2352x1568.
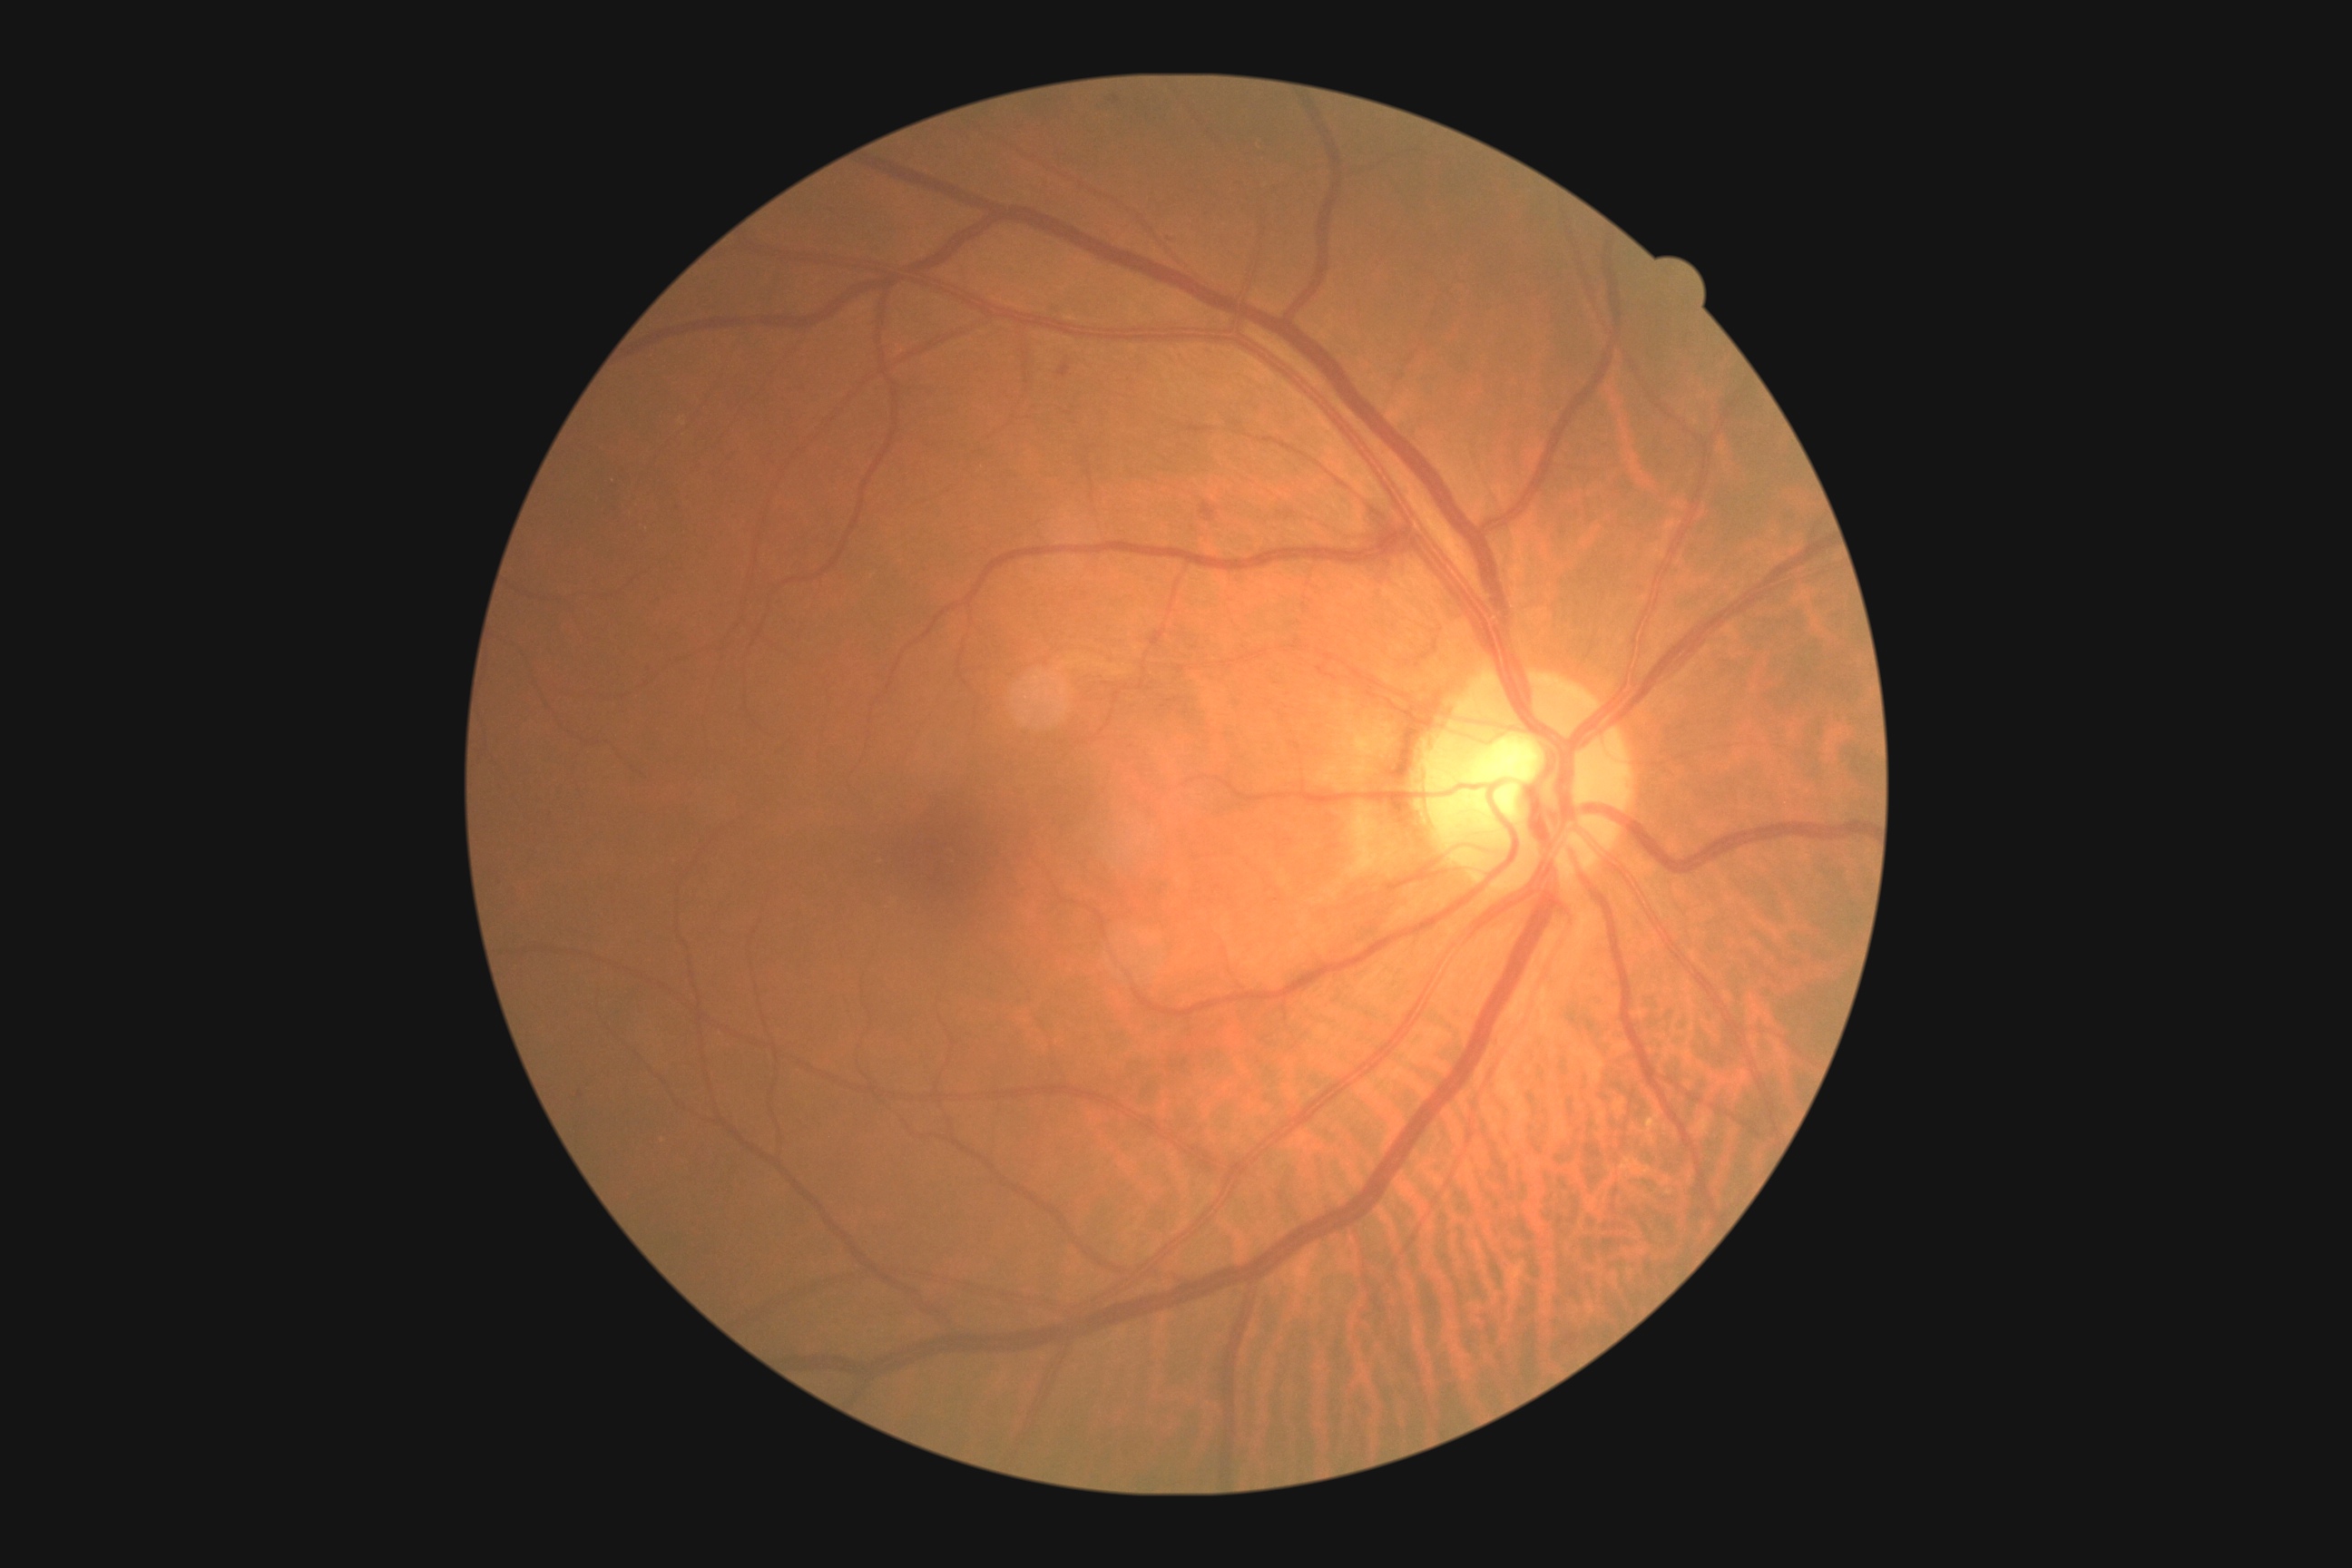
Annotations:
- DR severity: grade 2 — more than just microaneurysms but less than severe NPDR